NIDEK AFC-230 fundus camera, posterior pole photograph, nonmydriatic fundus photograph — 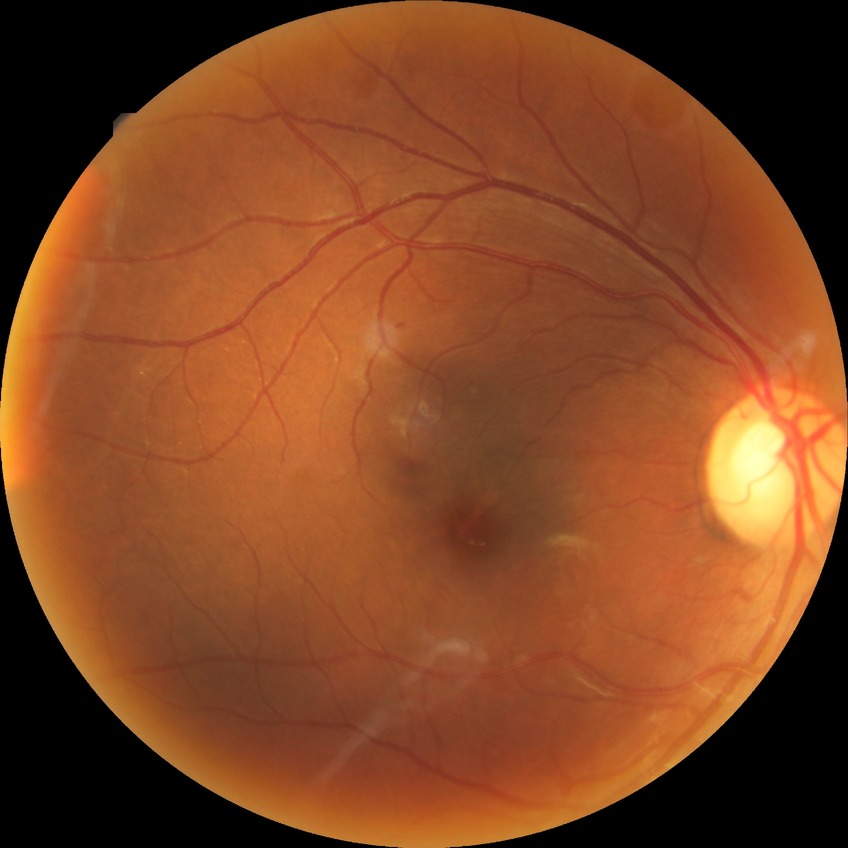
Diabetic retinopathy (DR): simple diabetic retinopathy (SDR).